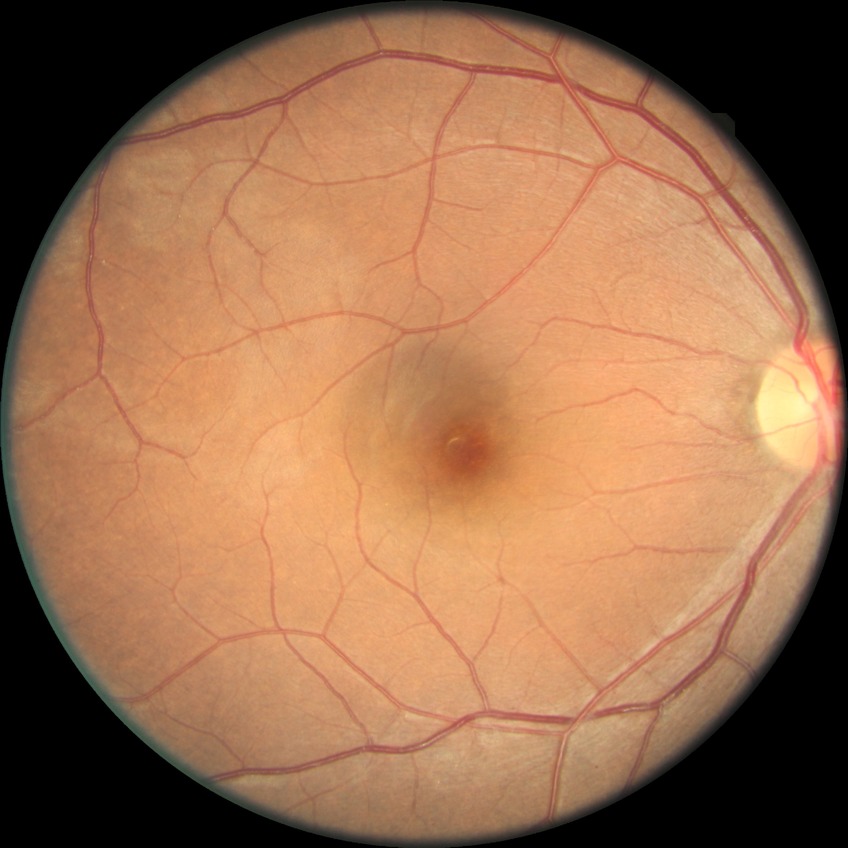

DR impression = no DR findings | Davis stage = NDR.